Wide-field contact fundus photograph of an infant. Acquired on the Phoenix ICON. 1240x1240px — 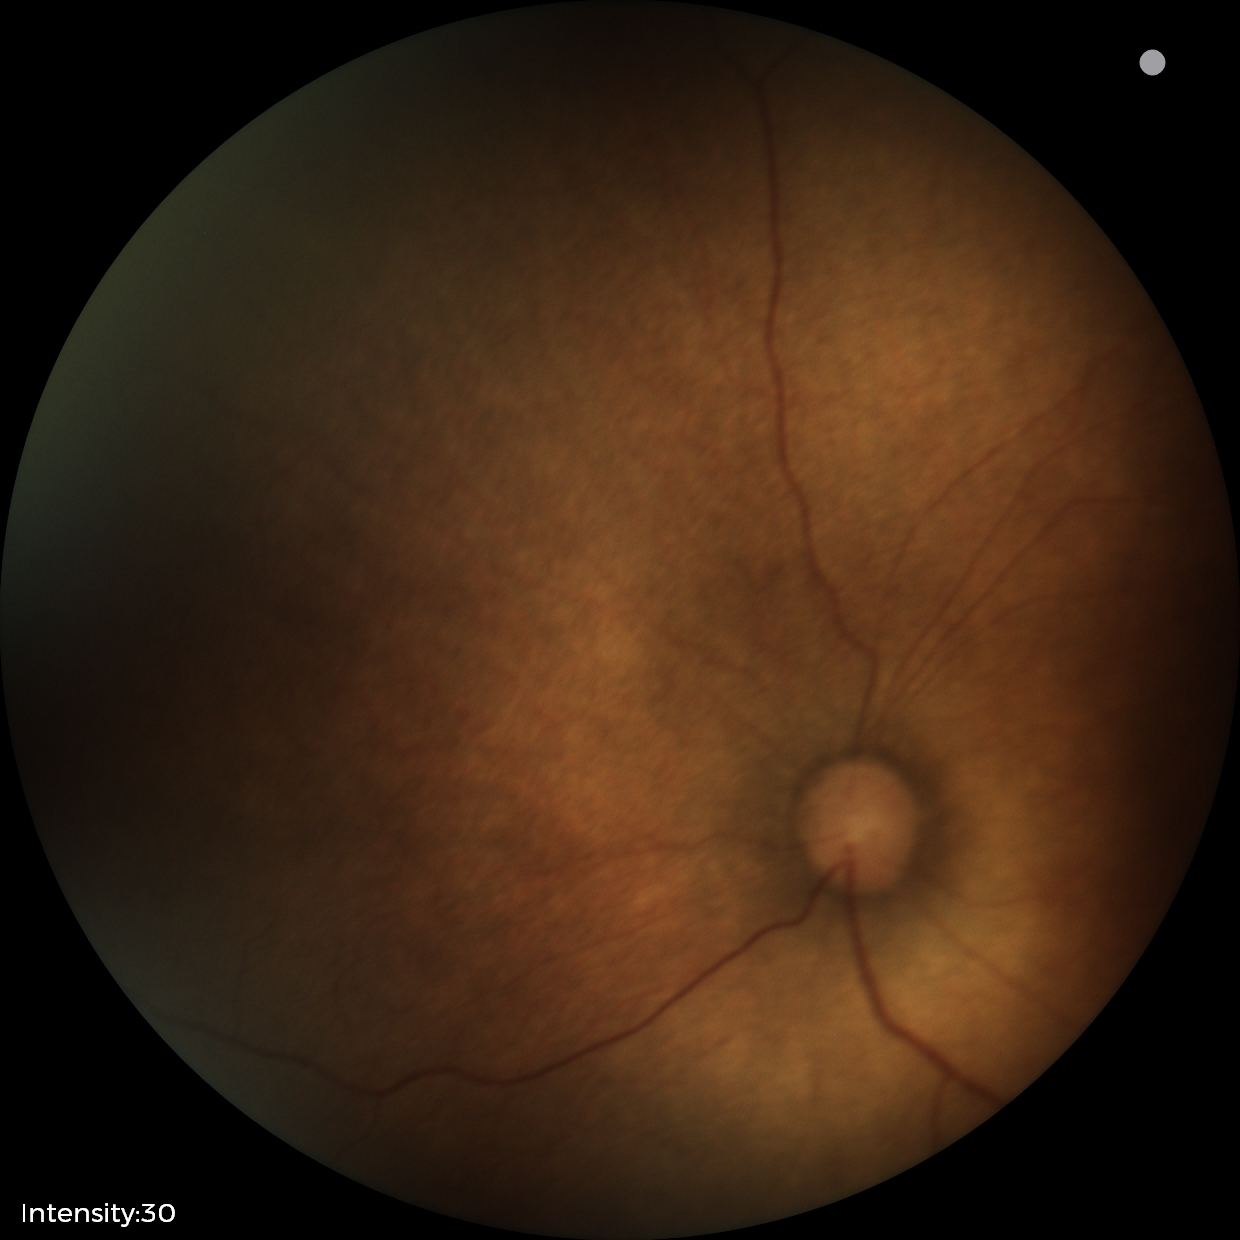
Q: What is the diagnosis from this examination?
A: no abnormal retinal findings